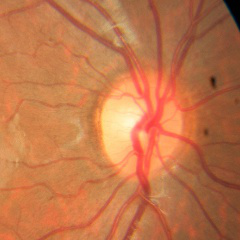

Glaucoma assessment: no glaucomatous optic neuropathy.